RetCam wide-field infant fundus image.
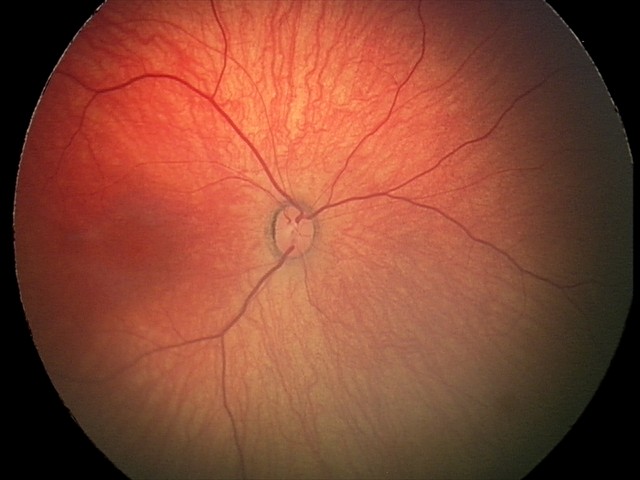

Screening diagnosis: retinal hemorrhages.